1380 x 1382 pixels
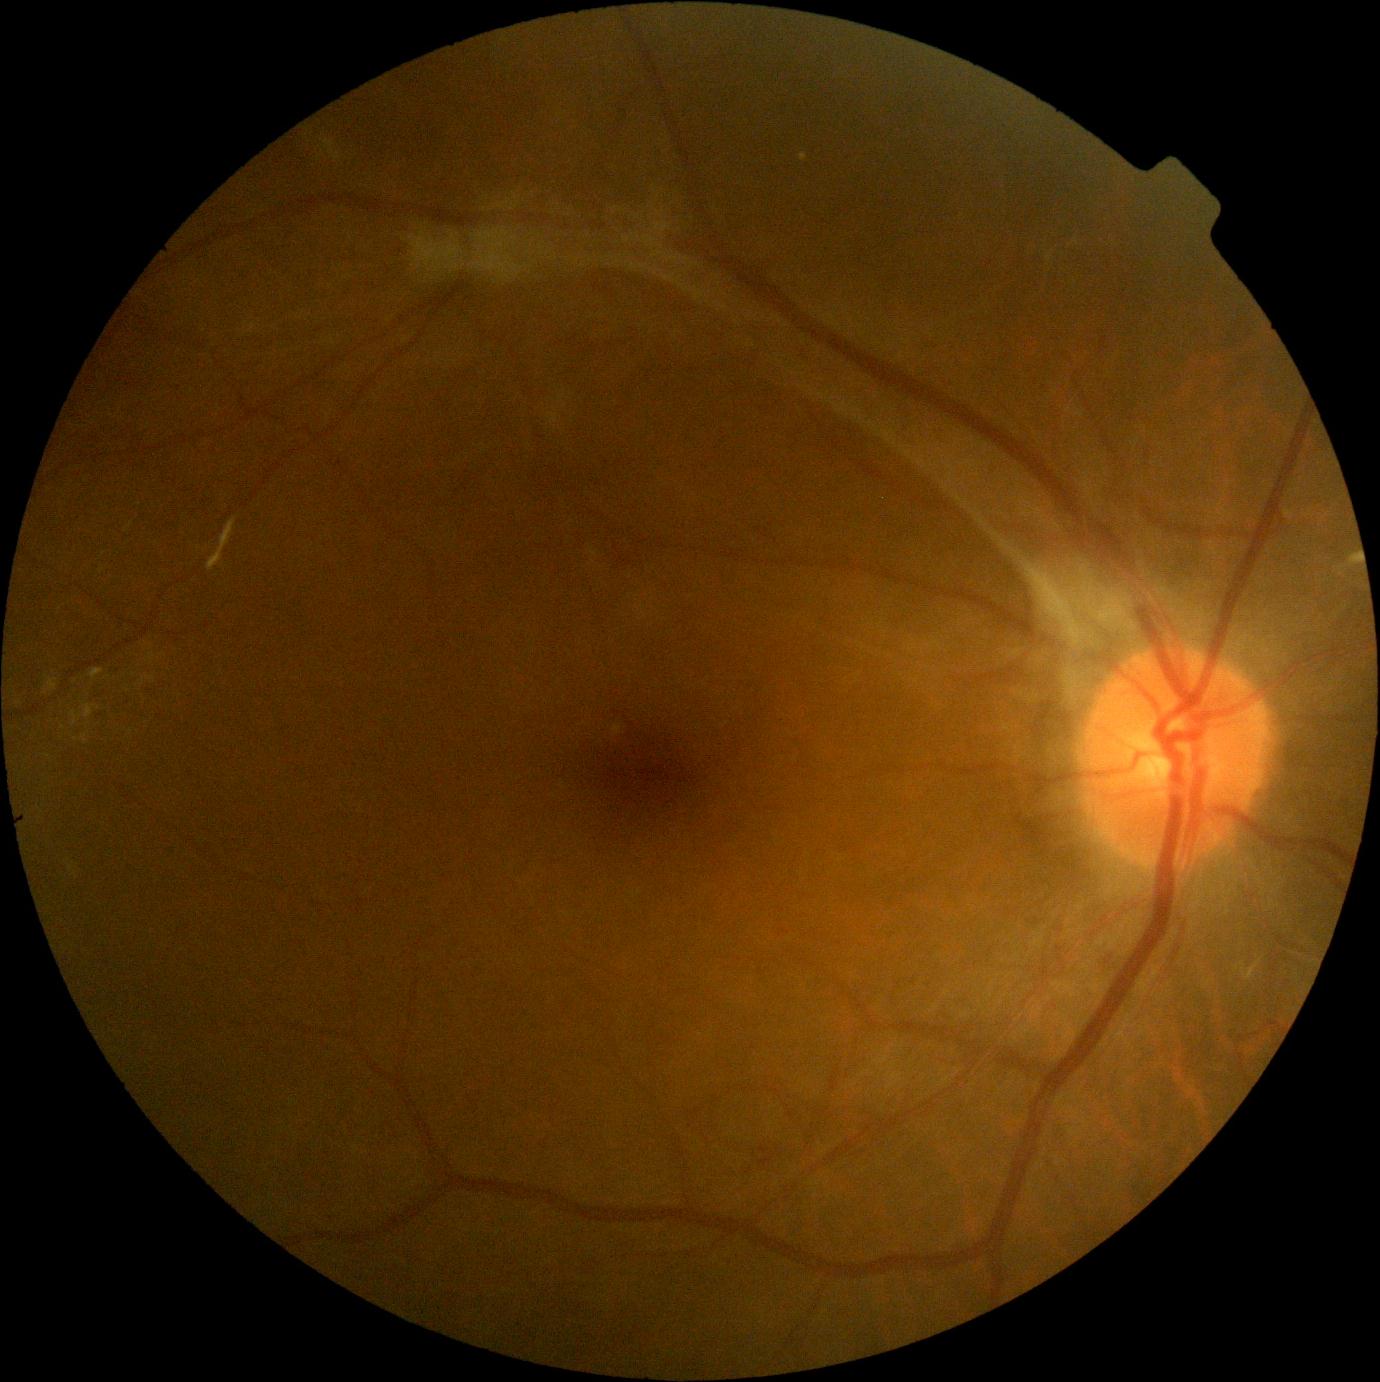

diabetic retinopathy (DR)@4 — neovascularization and/or vitreous/pre-retinal hemorrhage.